Non-mydriatic fundus camera
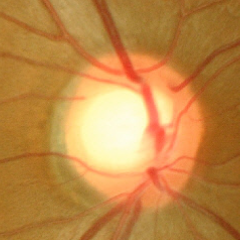 Fundus appearance consistent with no glaucoma.